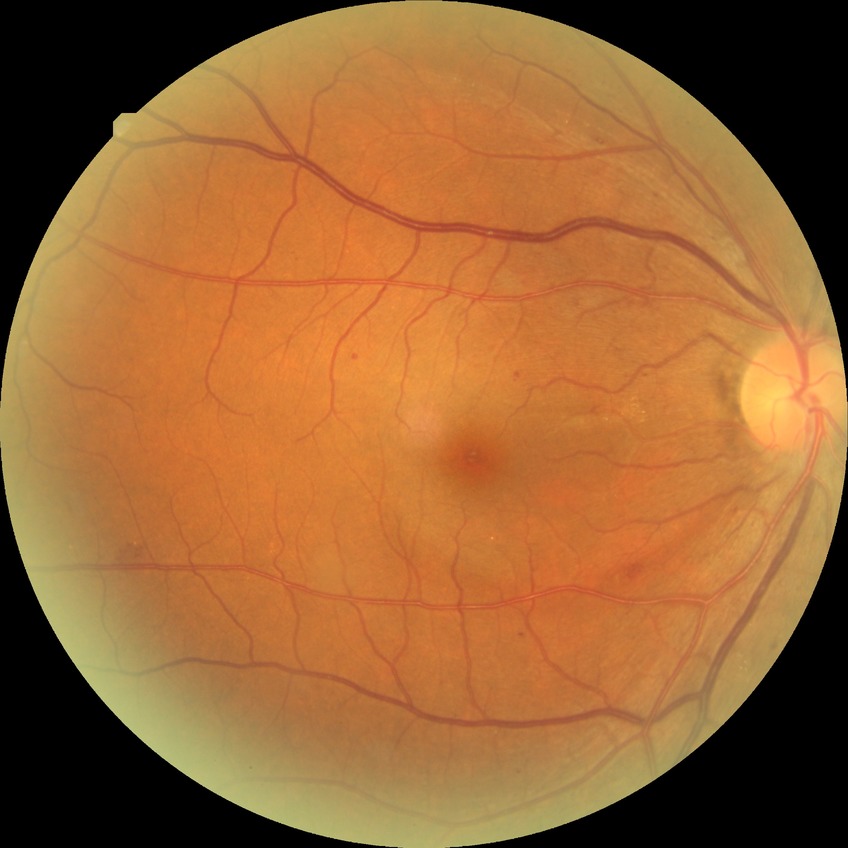

{
  "davis_grade": "simple diabetic retinopathy",
  "proliferative_class": "non-proliferative diabetic retinopathy"
}